Wide-field contact fundus photograph of an infant; acquired on the Clarity RetCam 3 — 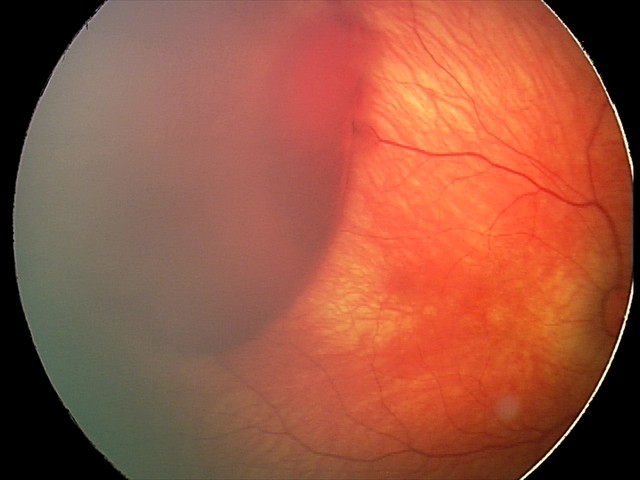
Q: What is the diagnosis from this examination?
A: retinal hemorrhages